45-degree field of view. 1932x1910px
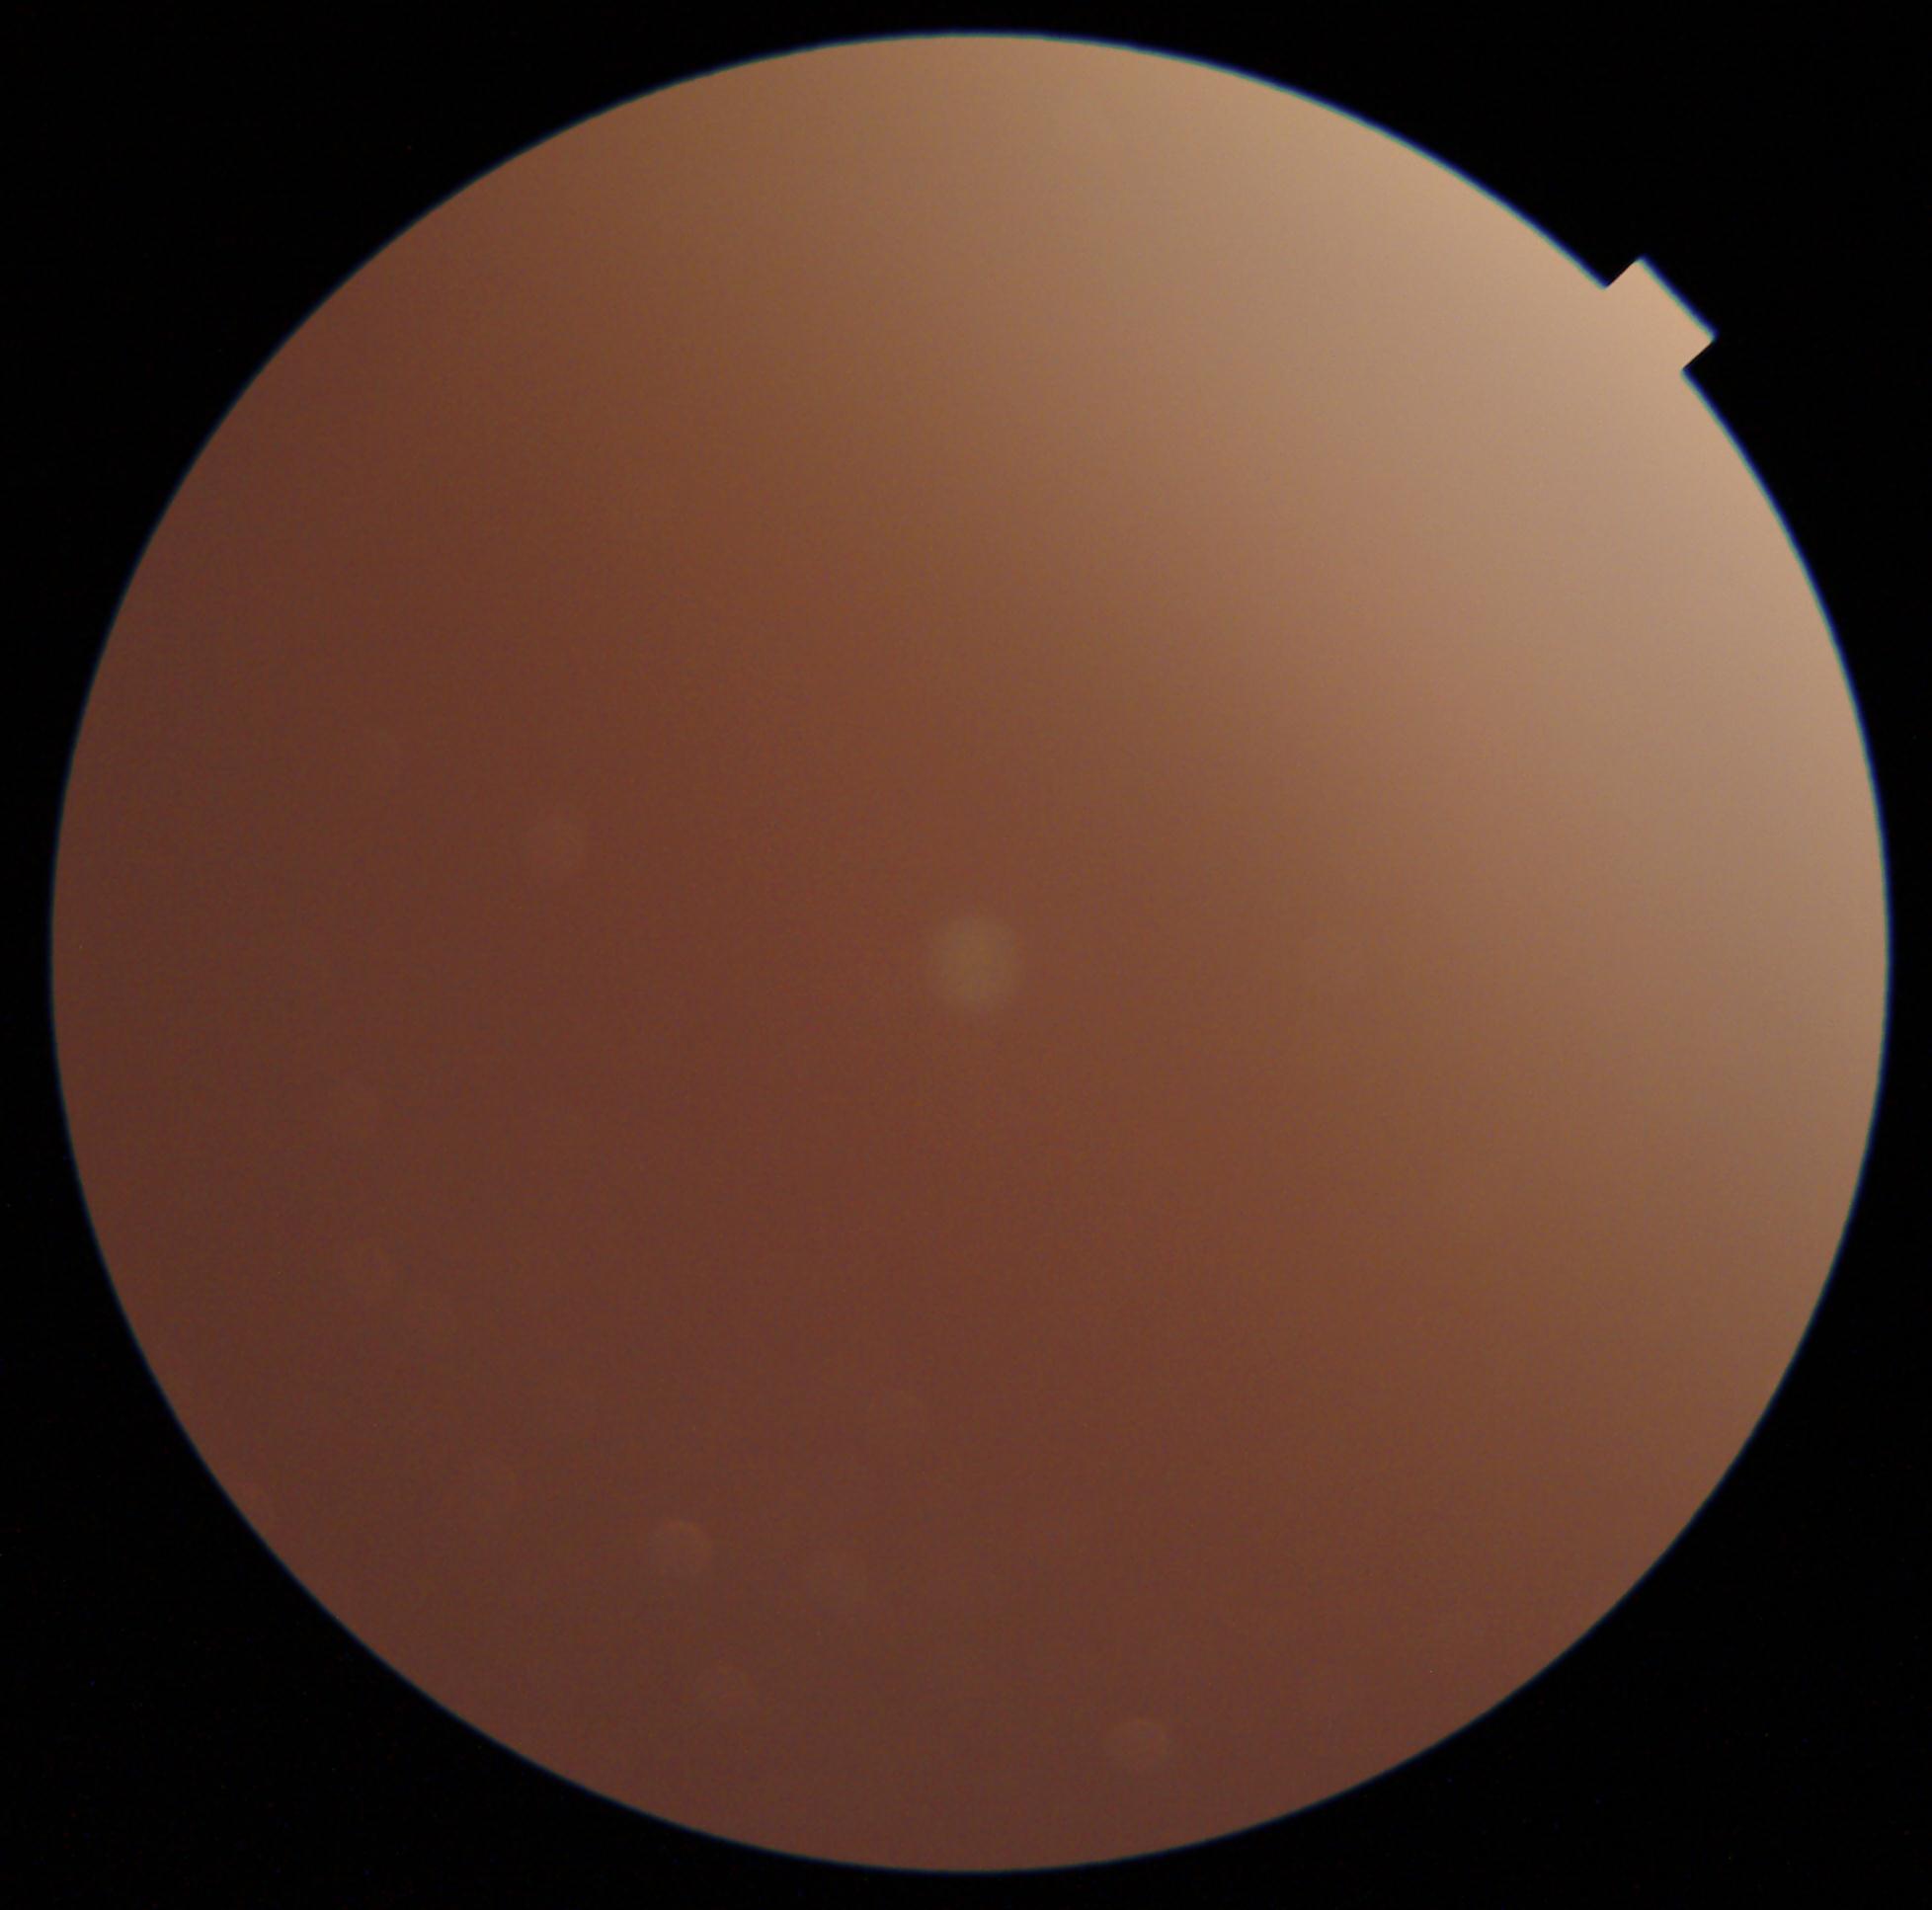 Ungradable image — DR severity cannot be determined. DR grade is ungradable.